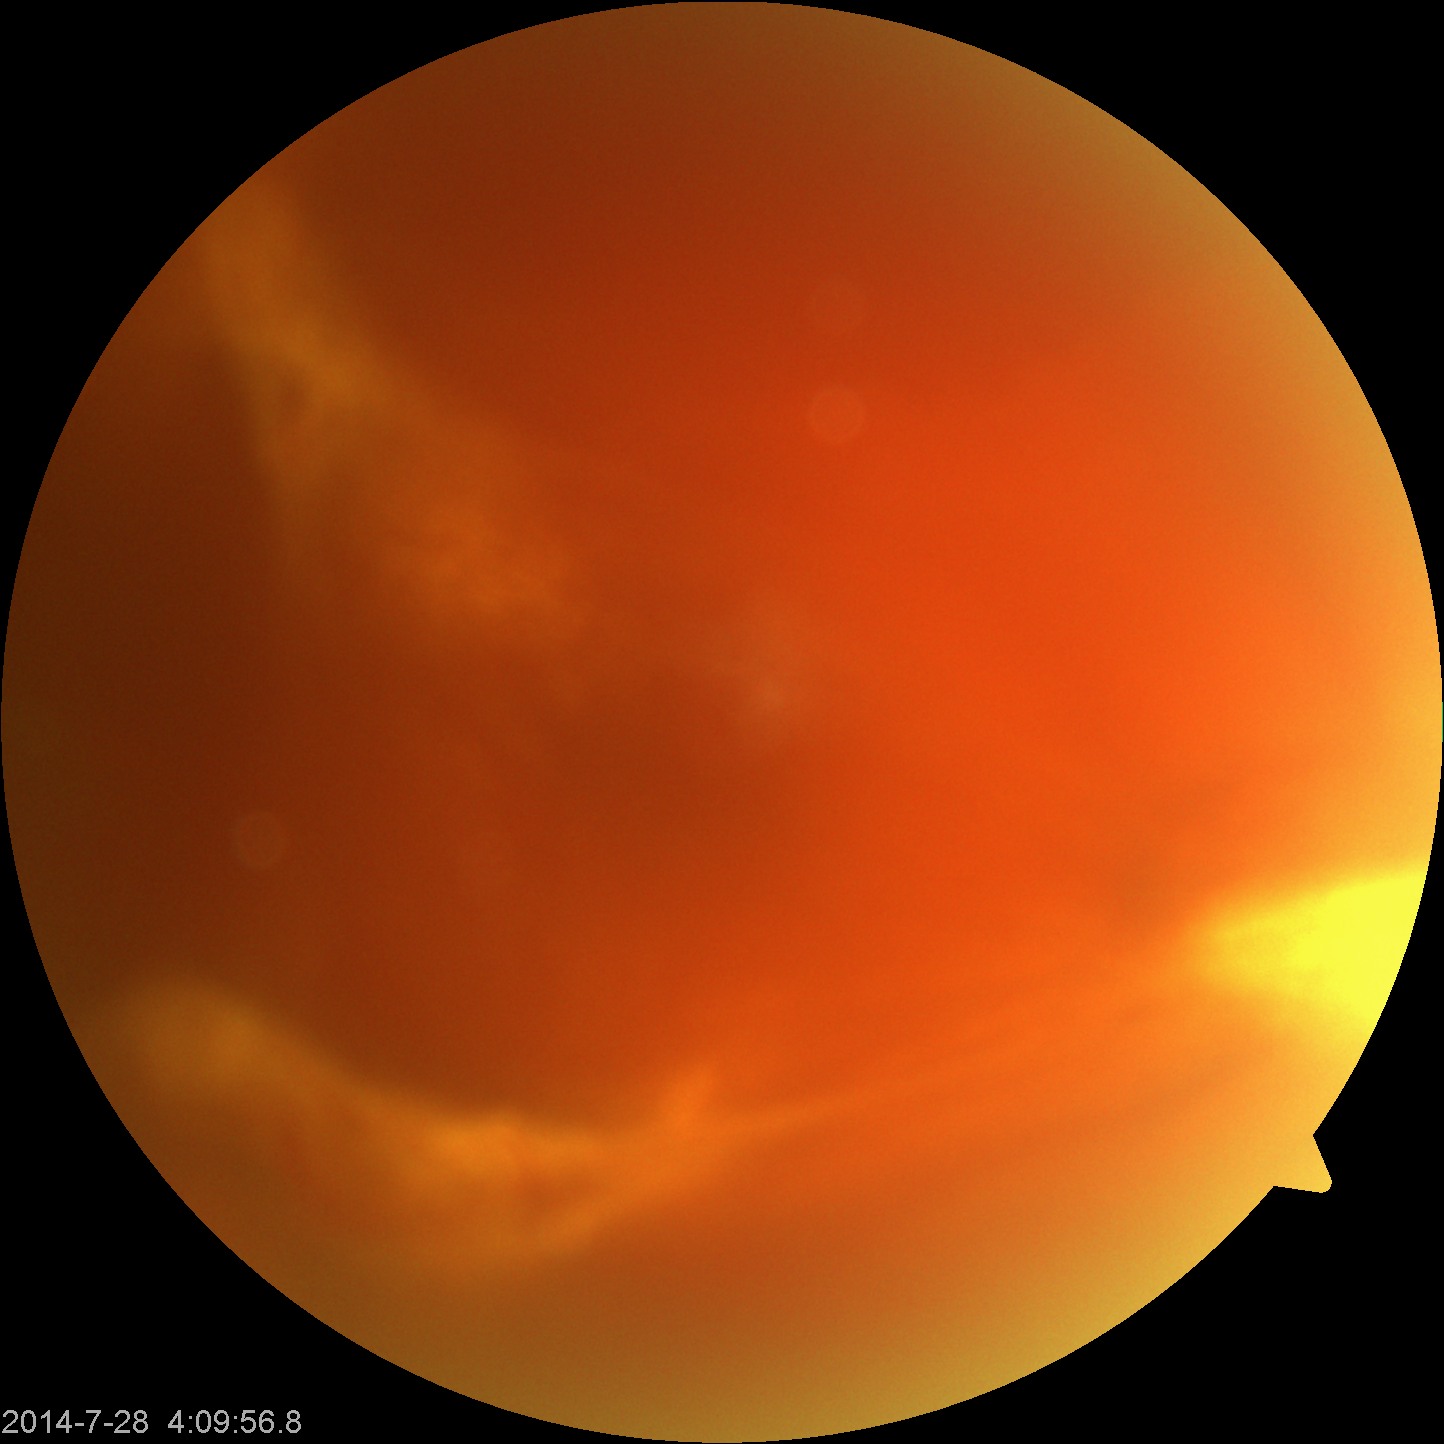 Gradability: blurred, more than half the field obscured.
Proliferative diabetic retinopathy: features suspicious.